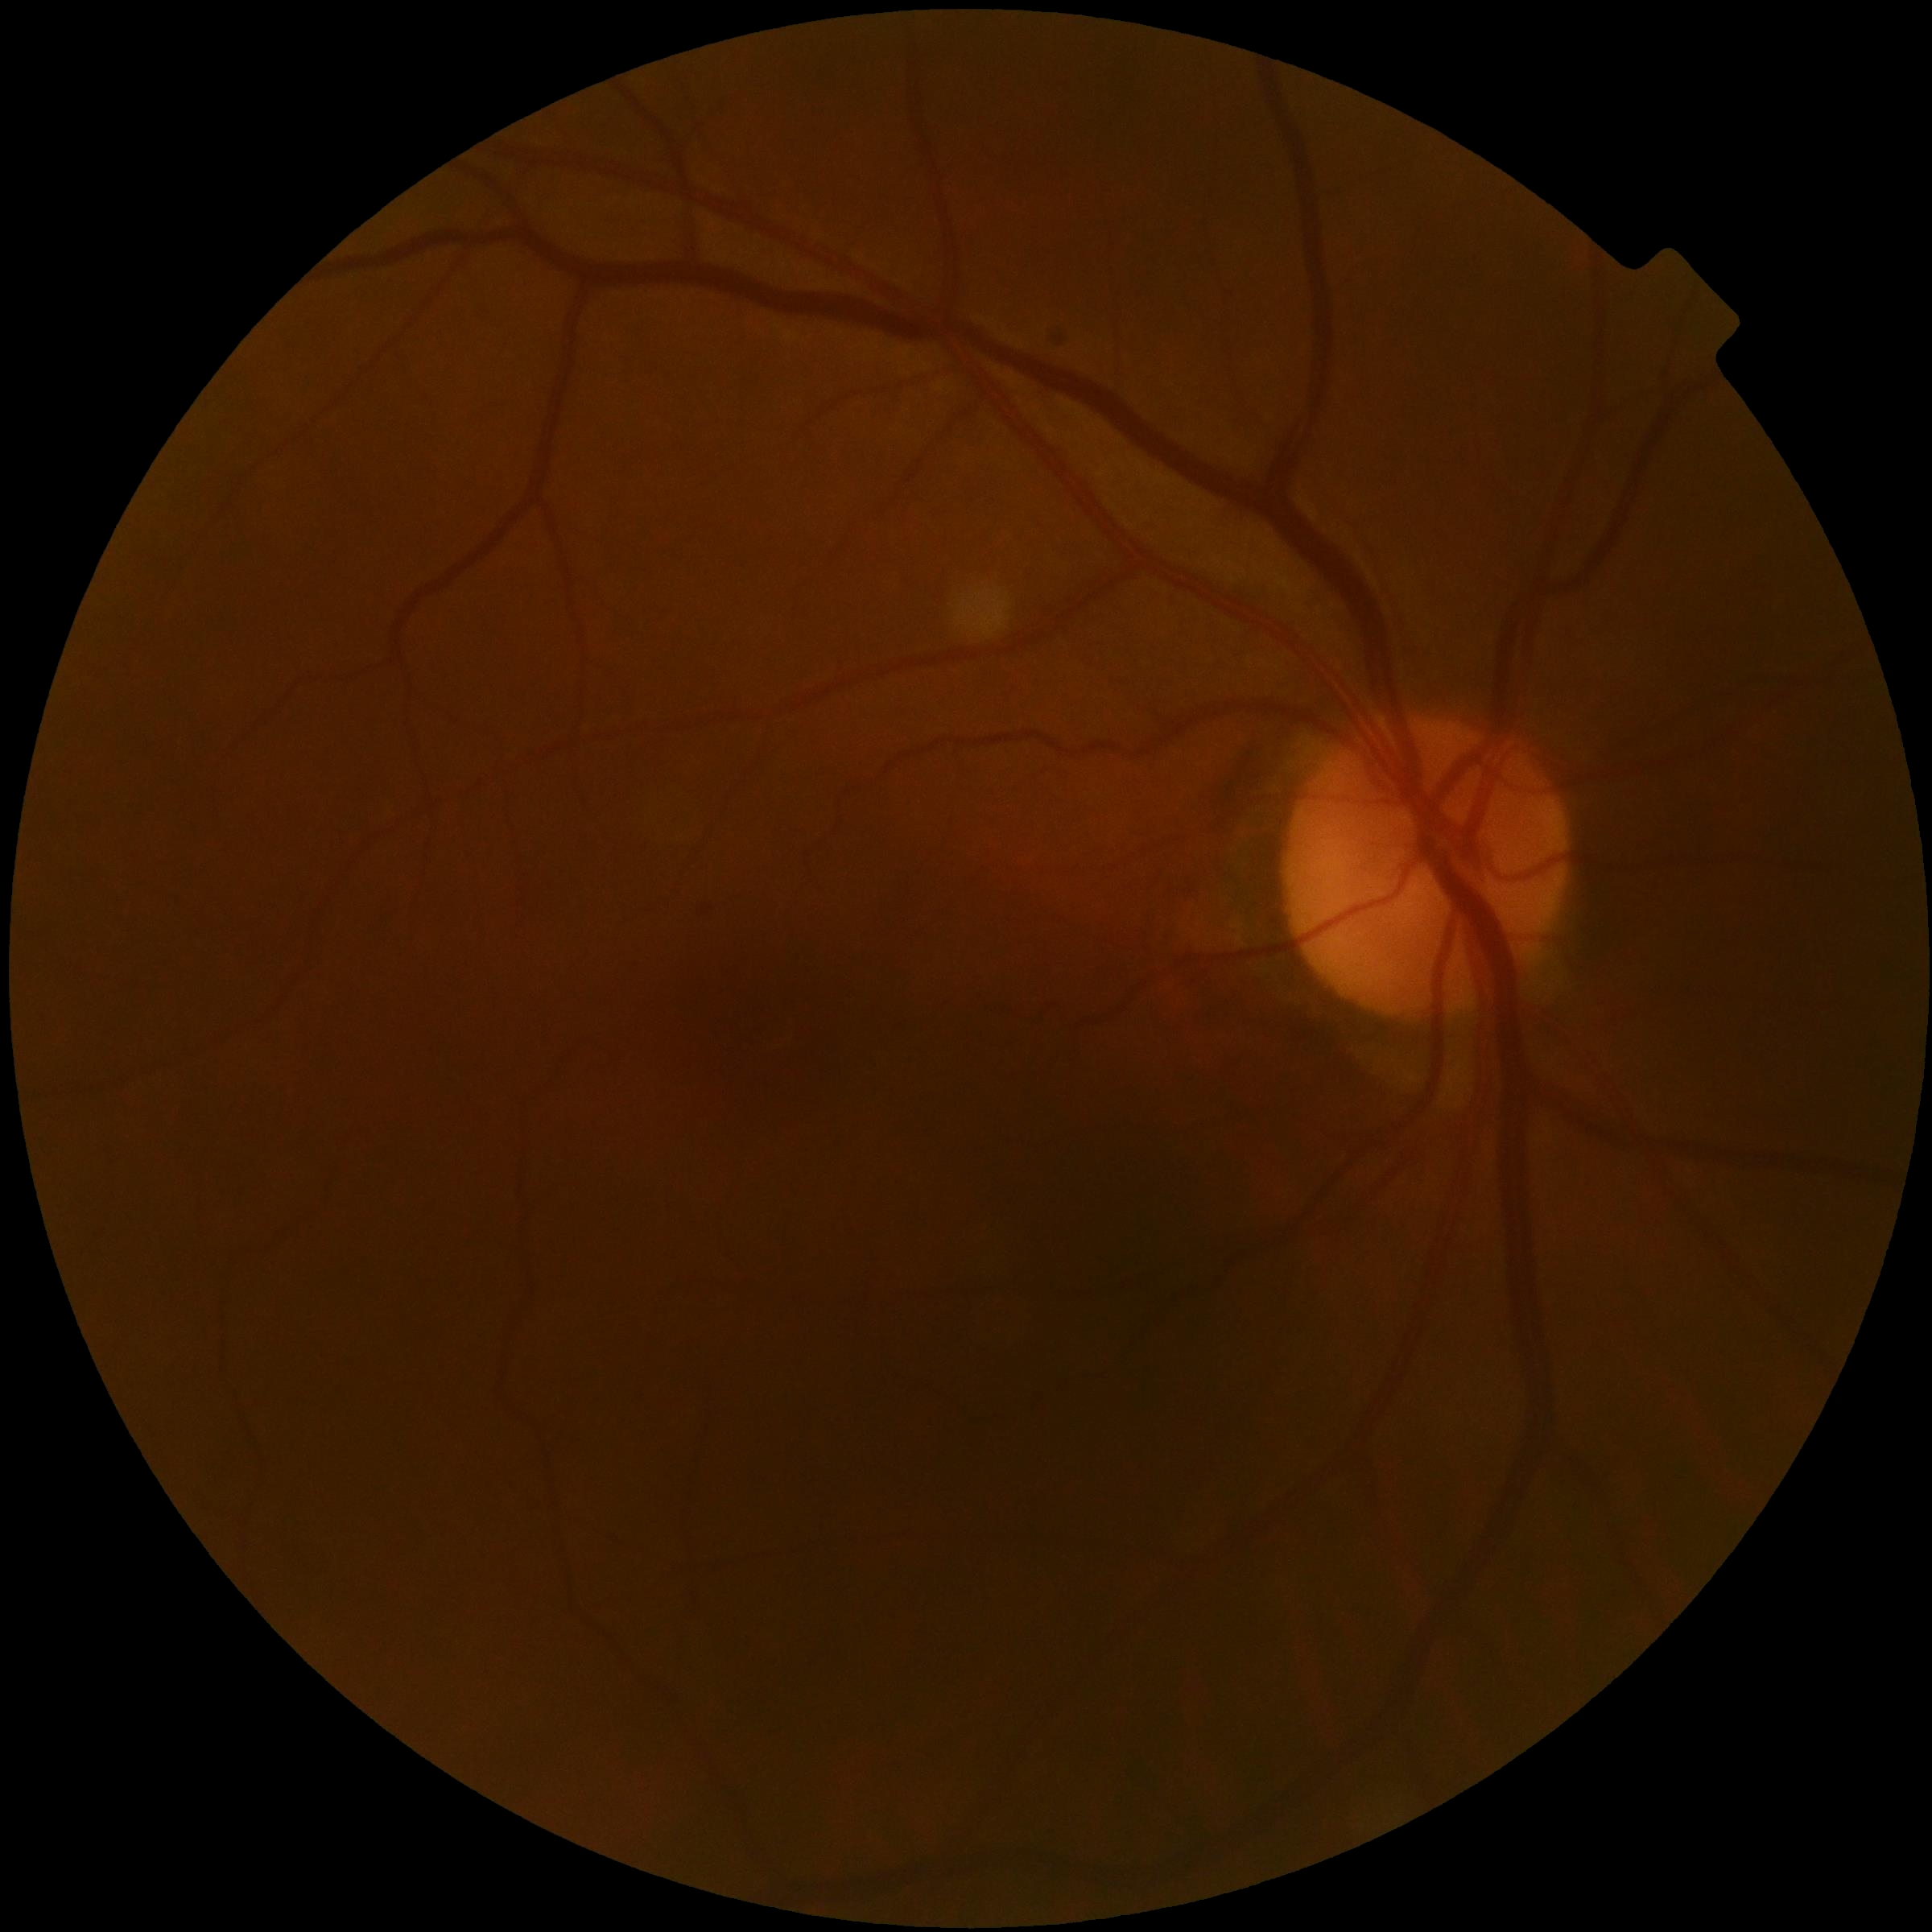
Diabetic retinopathy is 0.